Without pupil dilation. DR severity per modified Davis staging:
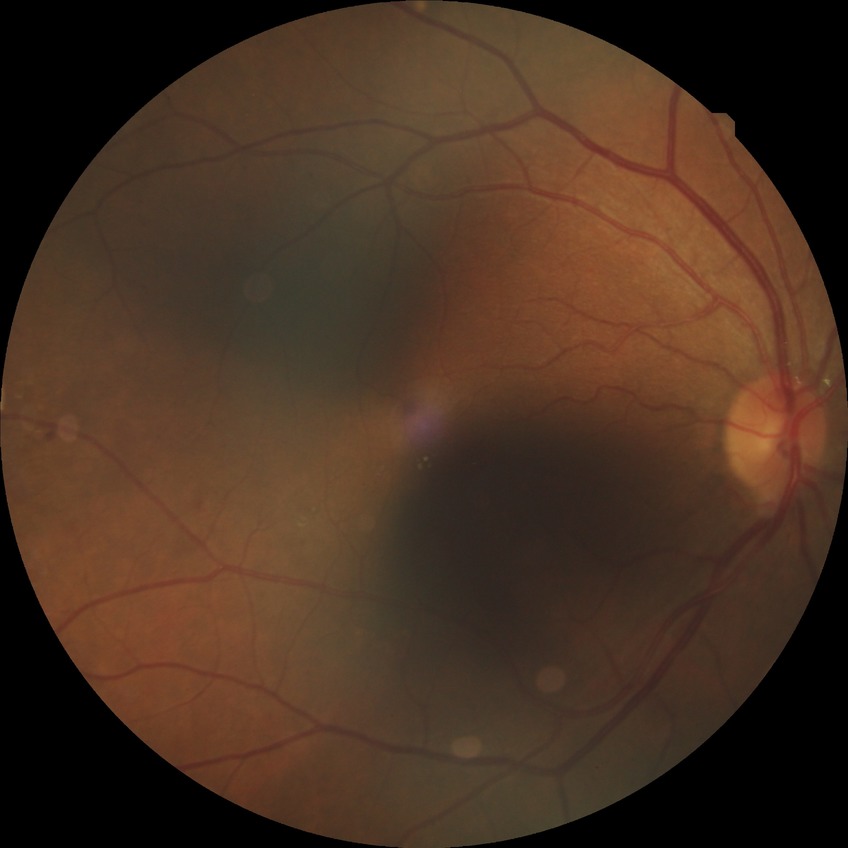 Diabetic retinopathy (DR) is SDR (simple diabetic retinopathy).